45° field of view, retinal fundus photograph, 1624 by 1232 pixels.
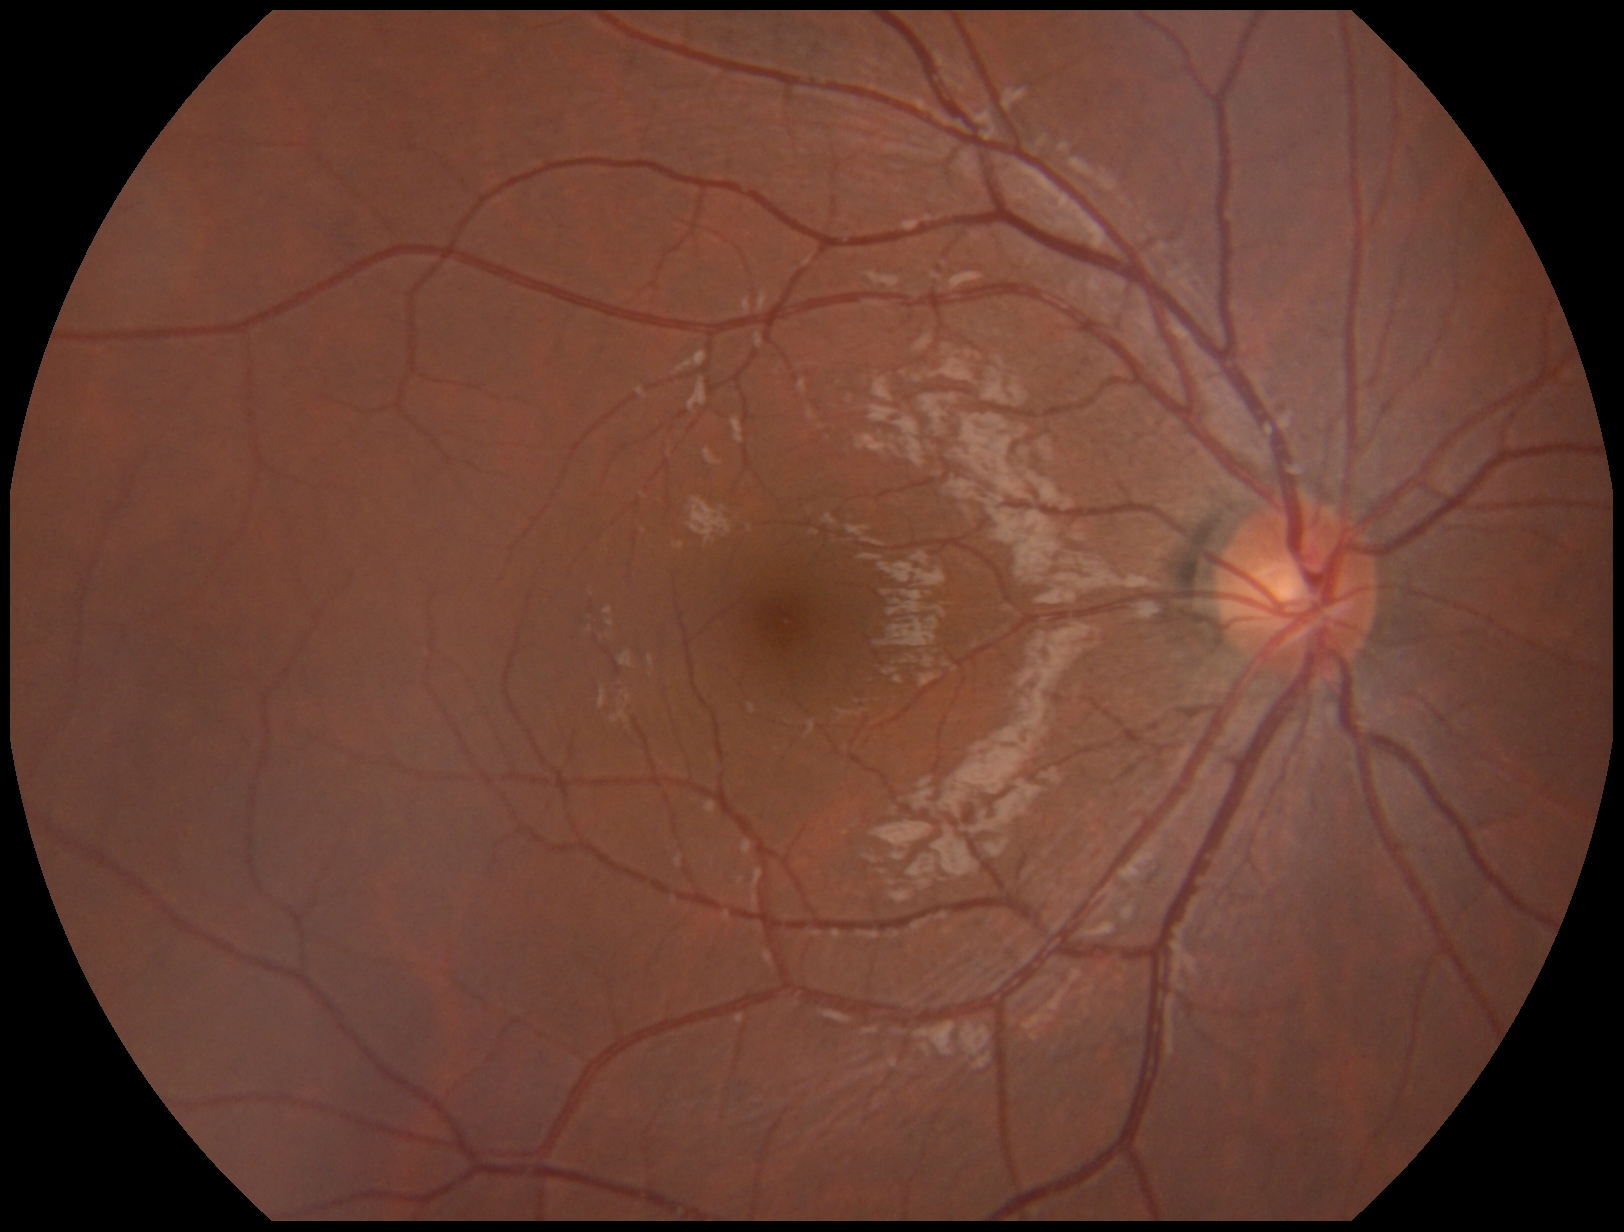
diabetic retinopathy (DR): 0/4.